Graded on the modified Davis scale · NIDEK AFC-230 — 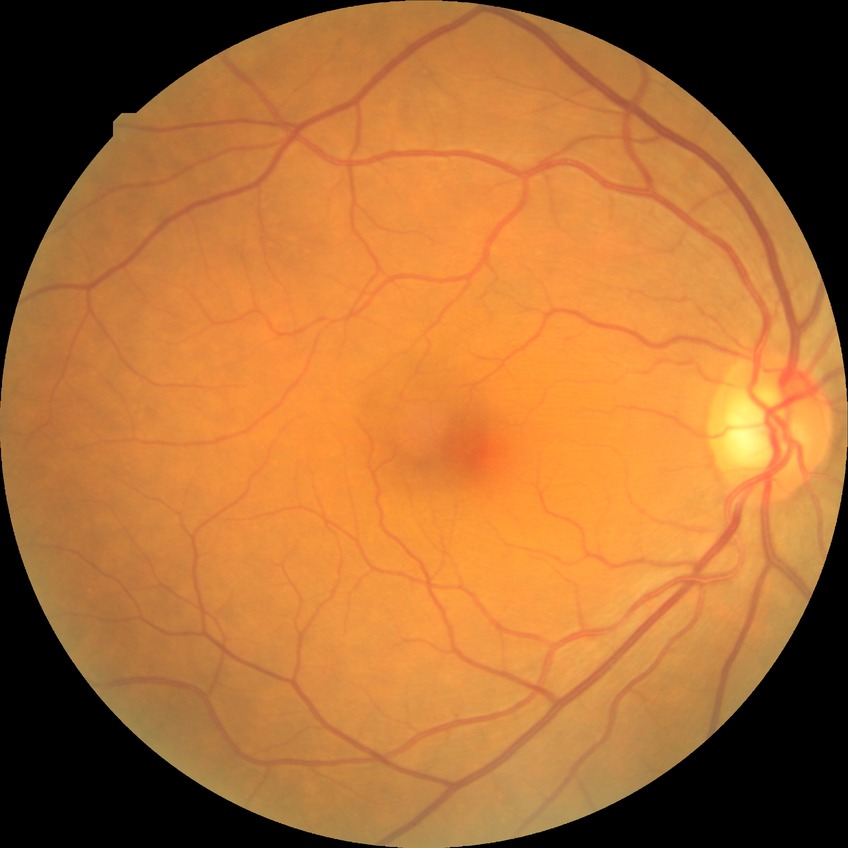 modified Davis grading=simple diabetic retinopathy.